Captured on a Remidio FOP fundus camera · 1659x2212px · retinal fundus photograph:
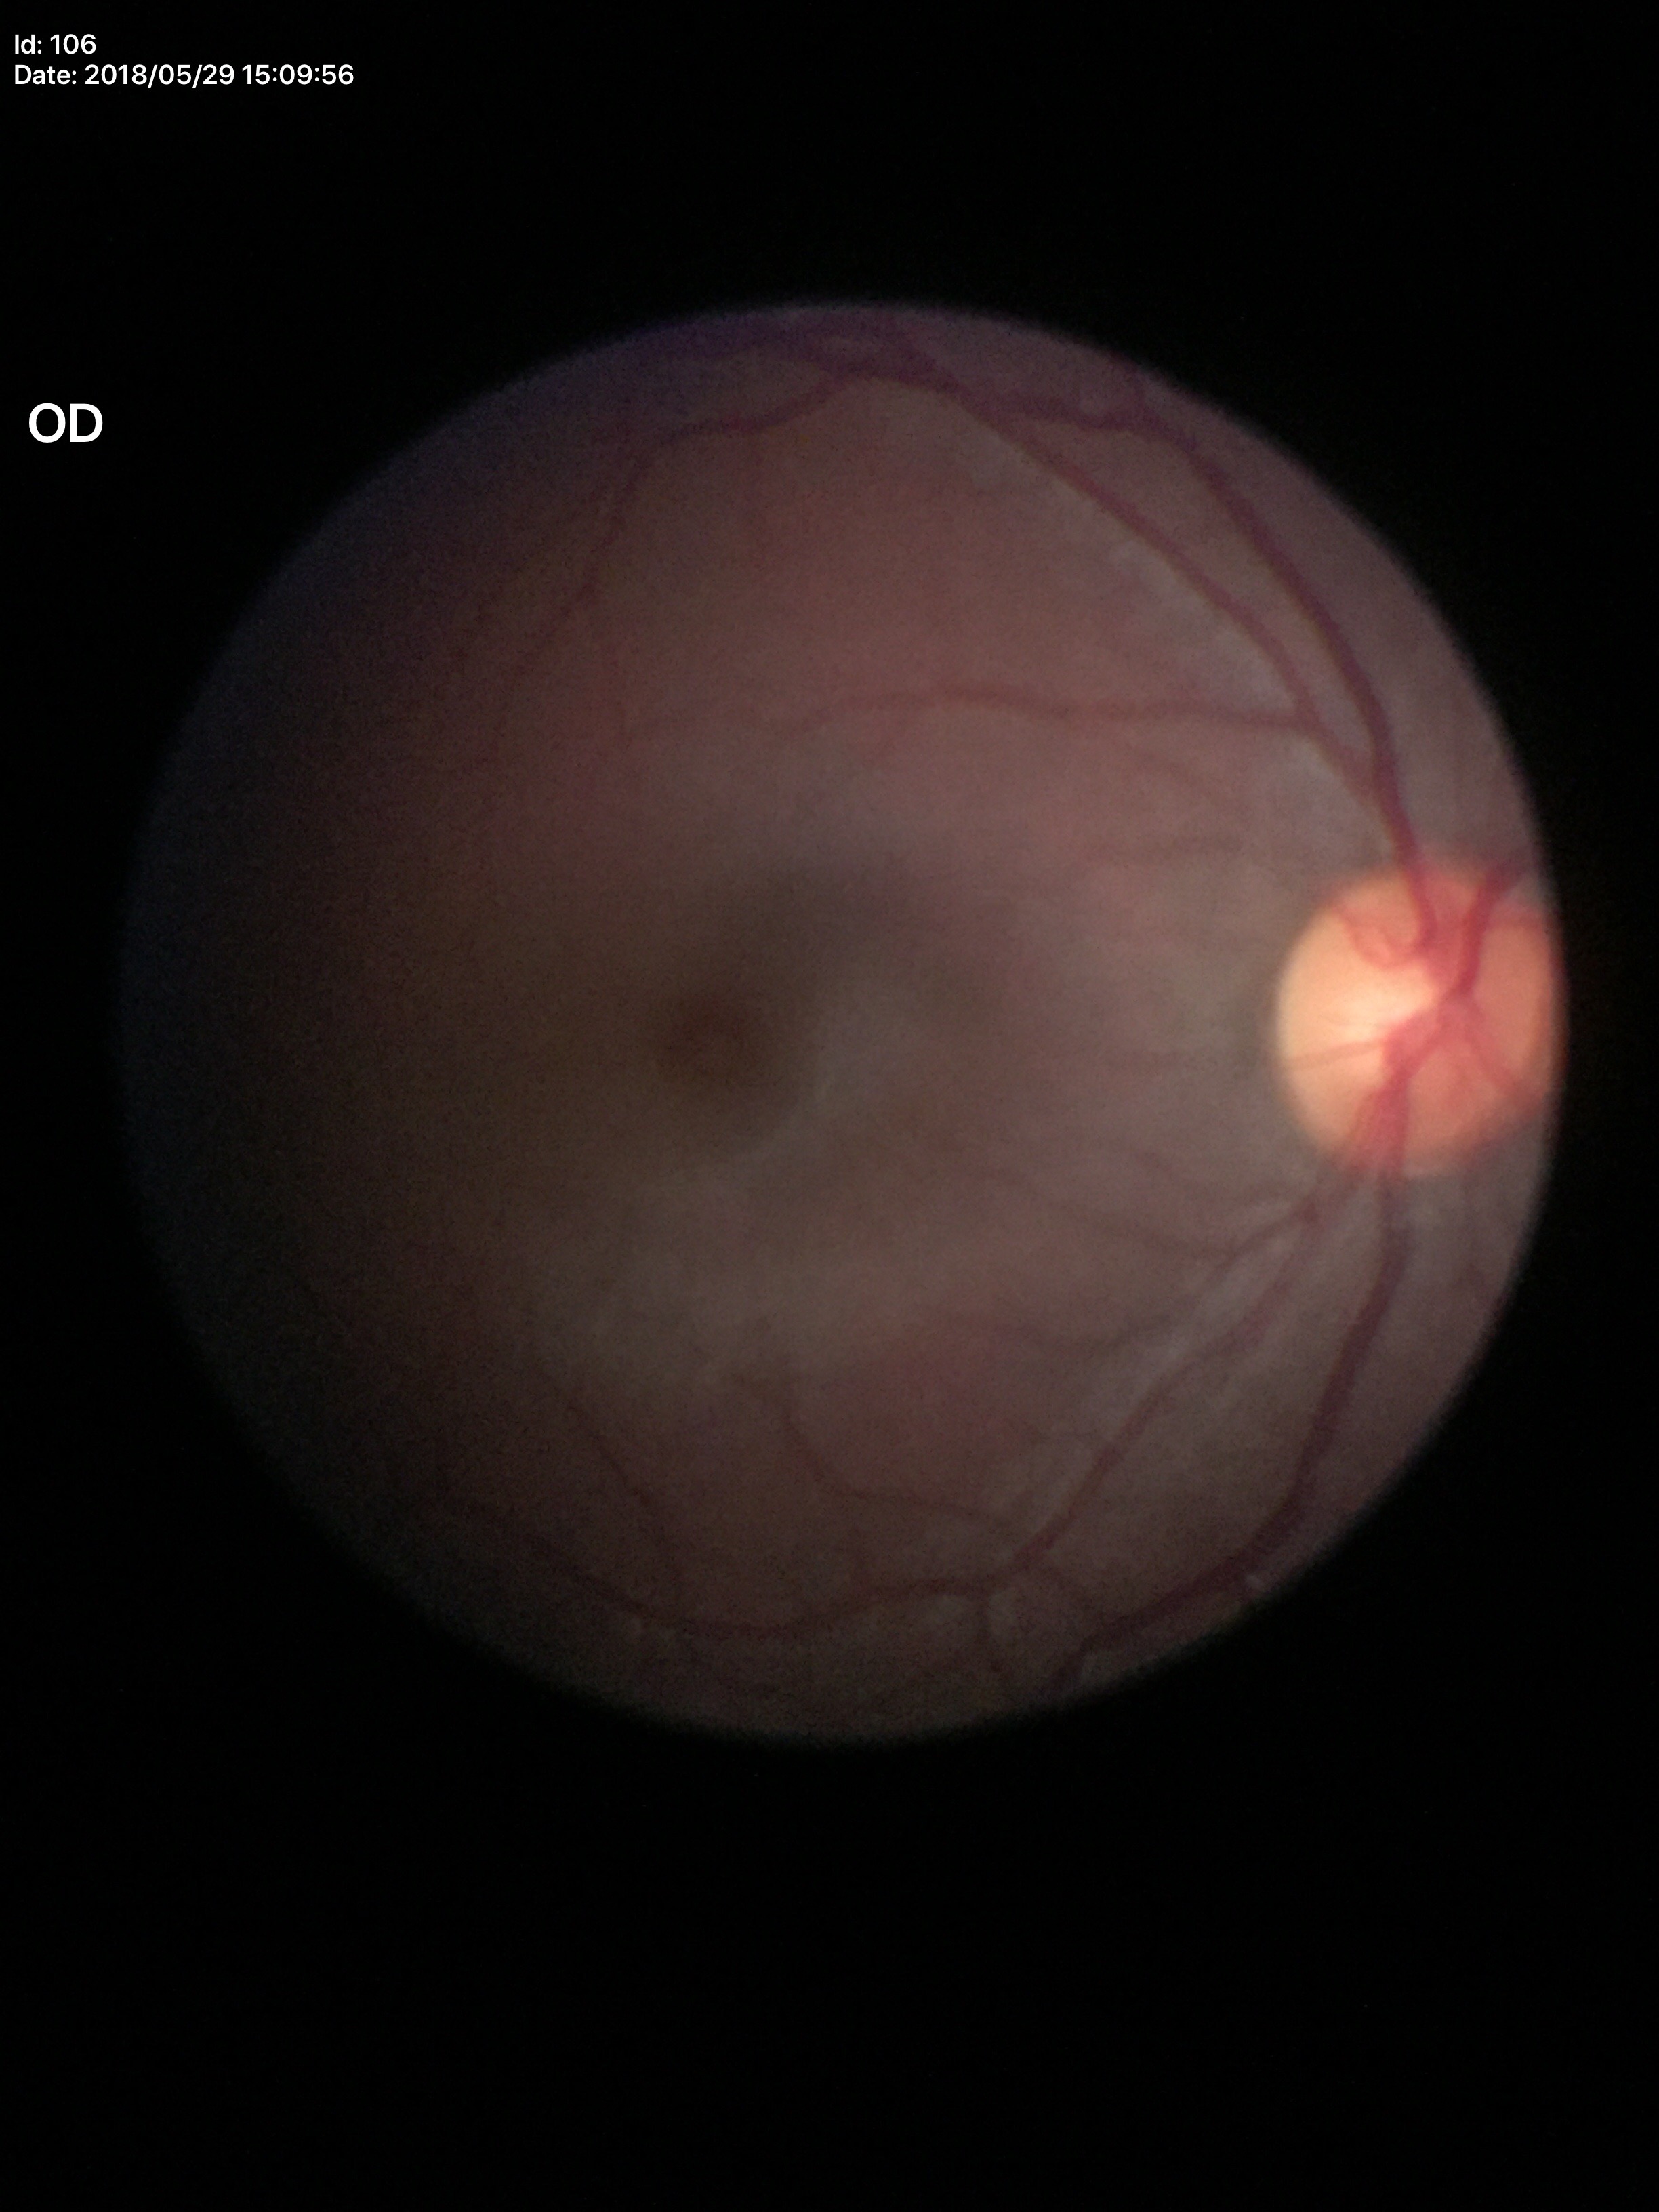

Optic disc analysis:
- Glaucoma assessment: no suspicious findings
- vertical cup-disc ratio: 0.48
- horizontal CDR: 0.48